Camera: Phoenix ICON (100° FOV) · 1240 by 1240 pixels · wide-field fundus image from infant ROP screening — 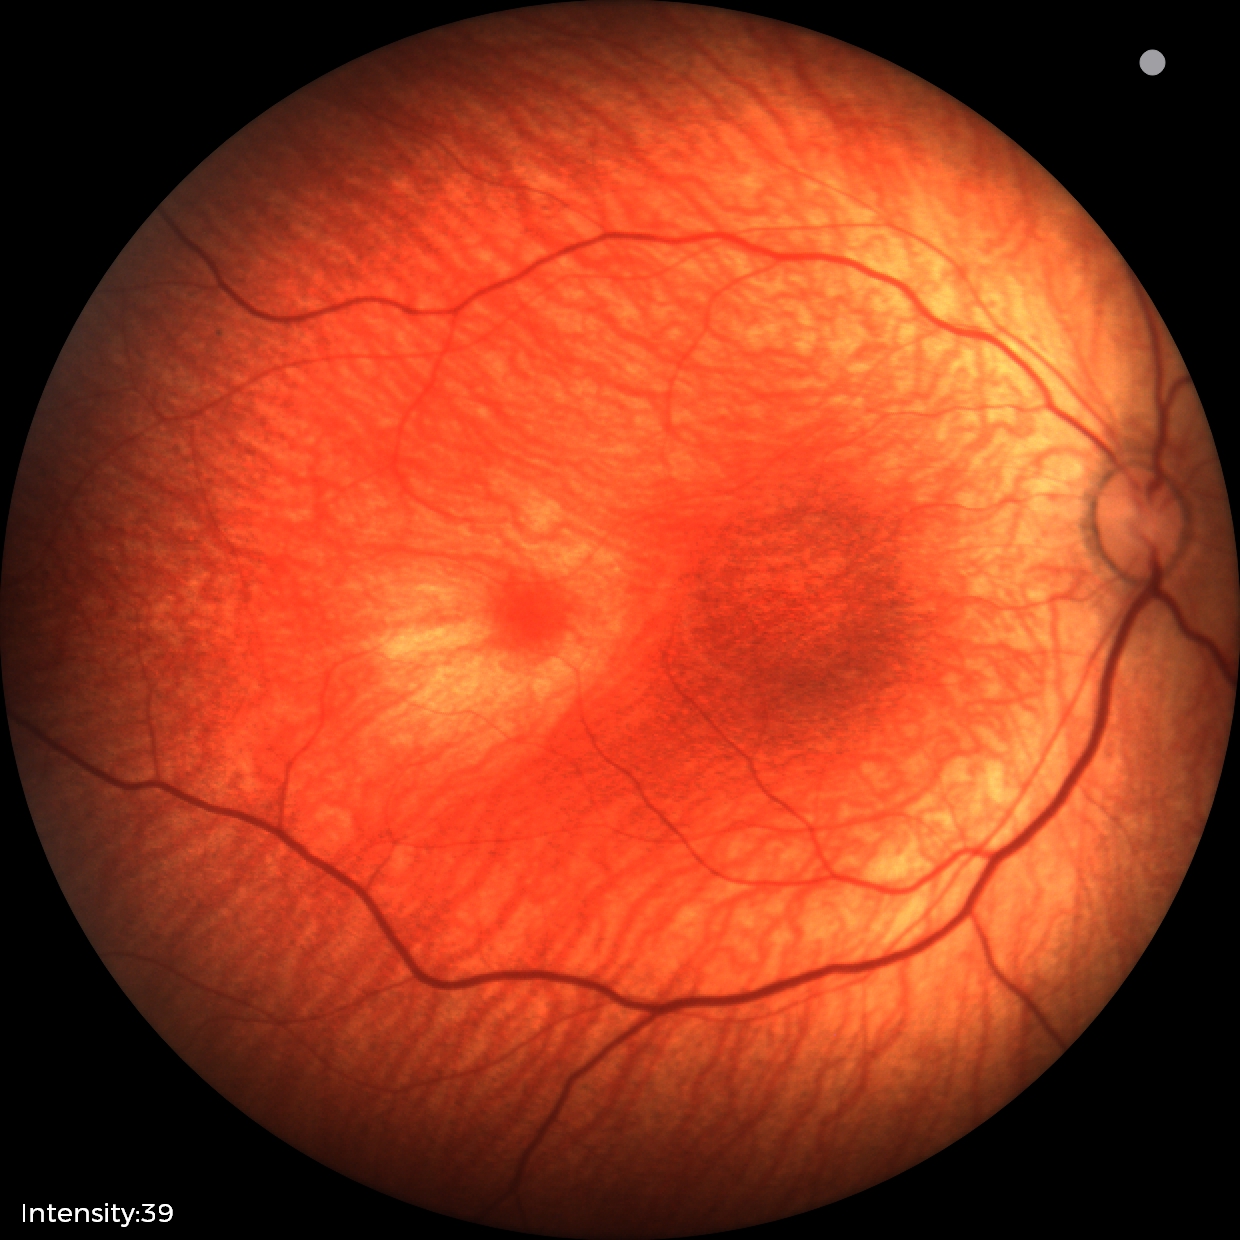 Assessment = normal.